45° FOV.
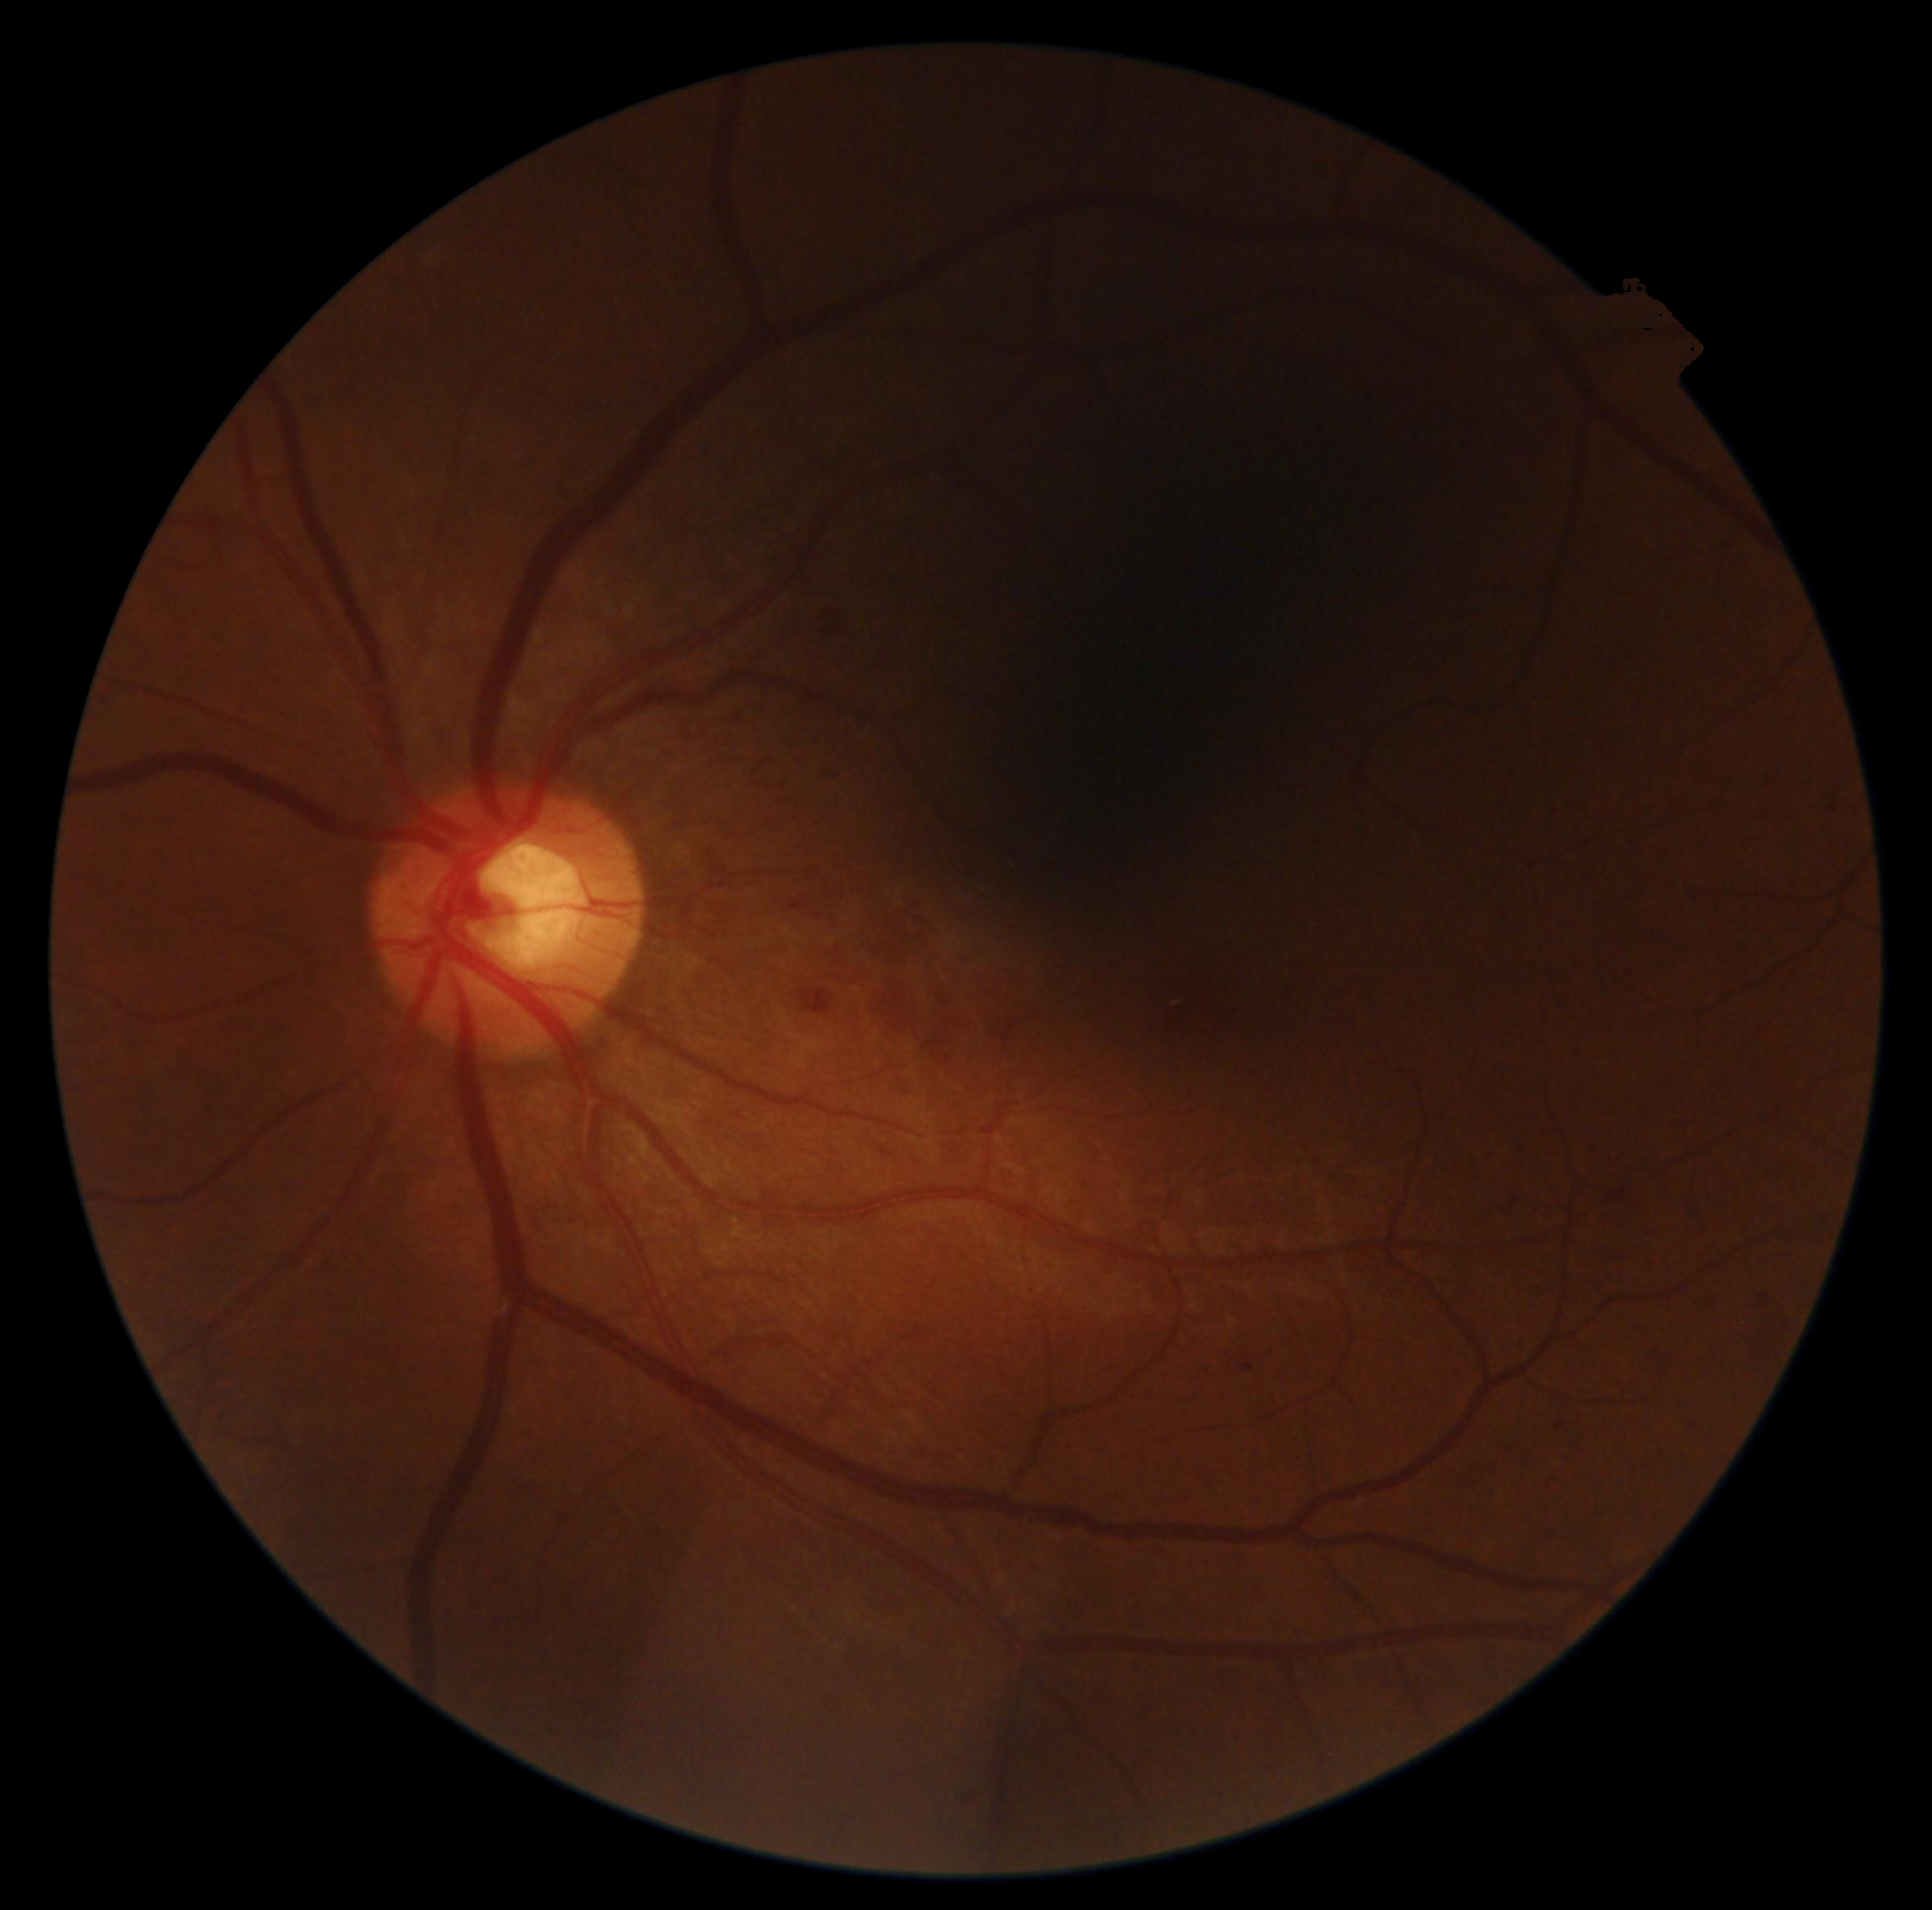
Diabetic retinopathy (DR): moderate NPDR (grade 2).